Image size 2352x1568. 45° field of view.
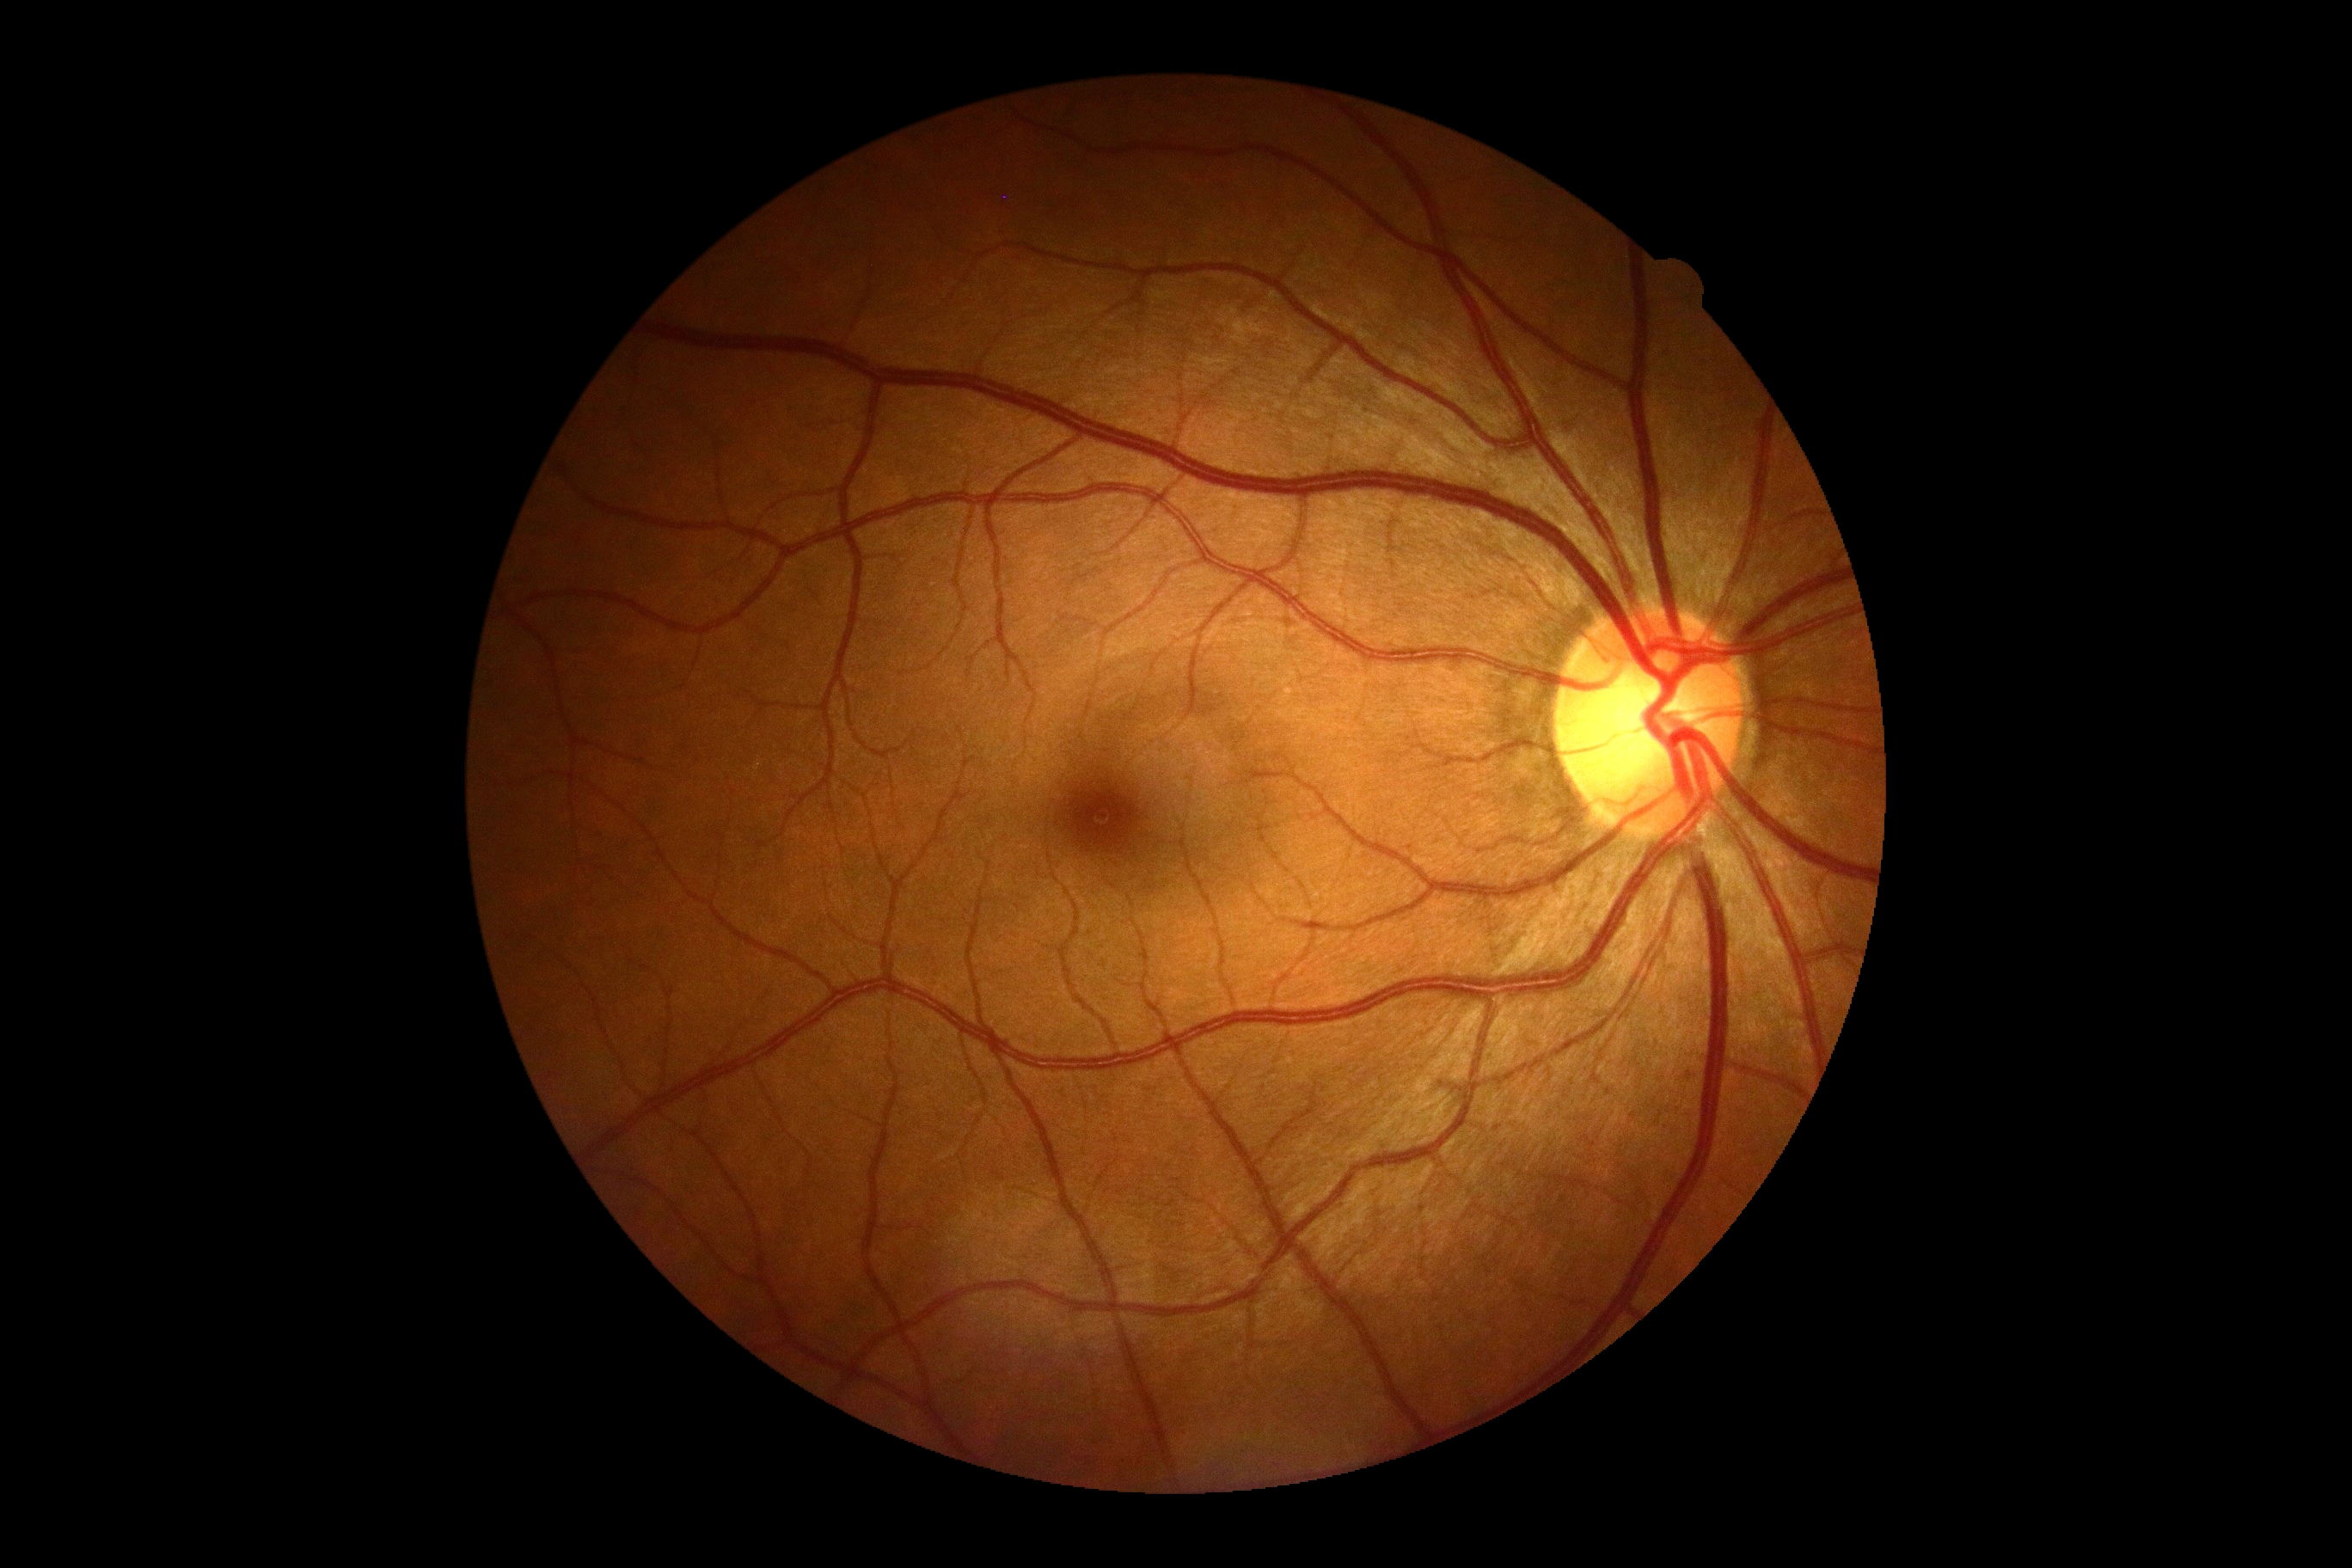

DR impression: negative for DR | DR grade: no apparent retinopathy (0).